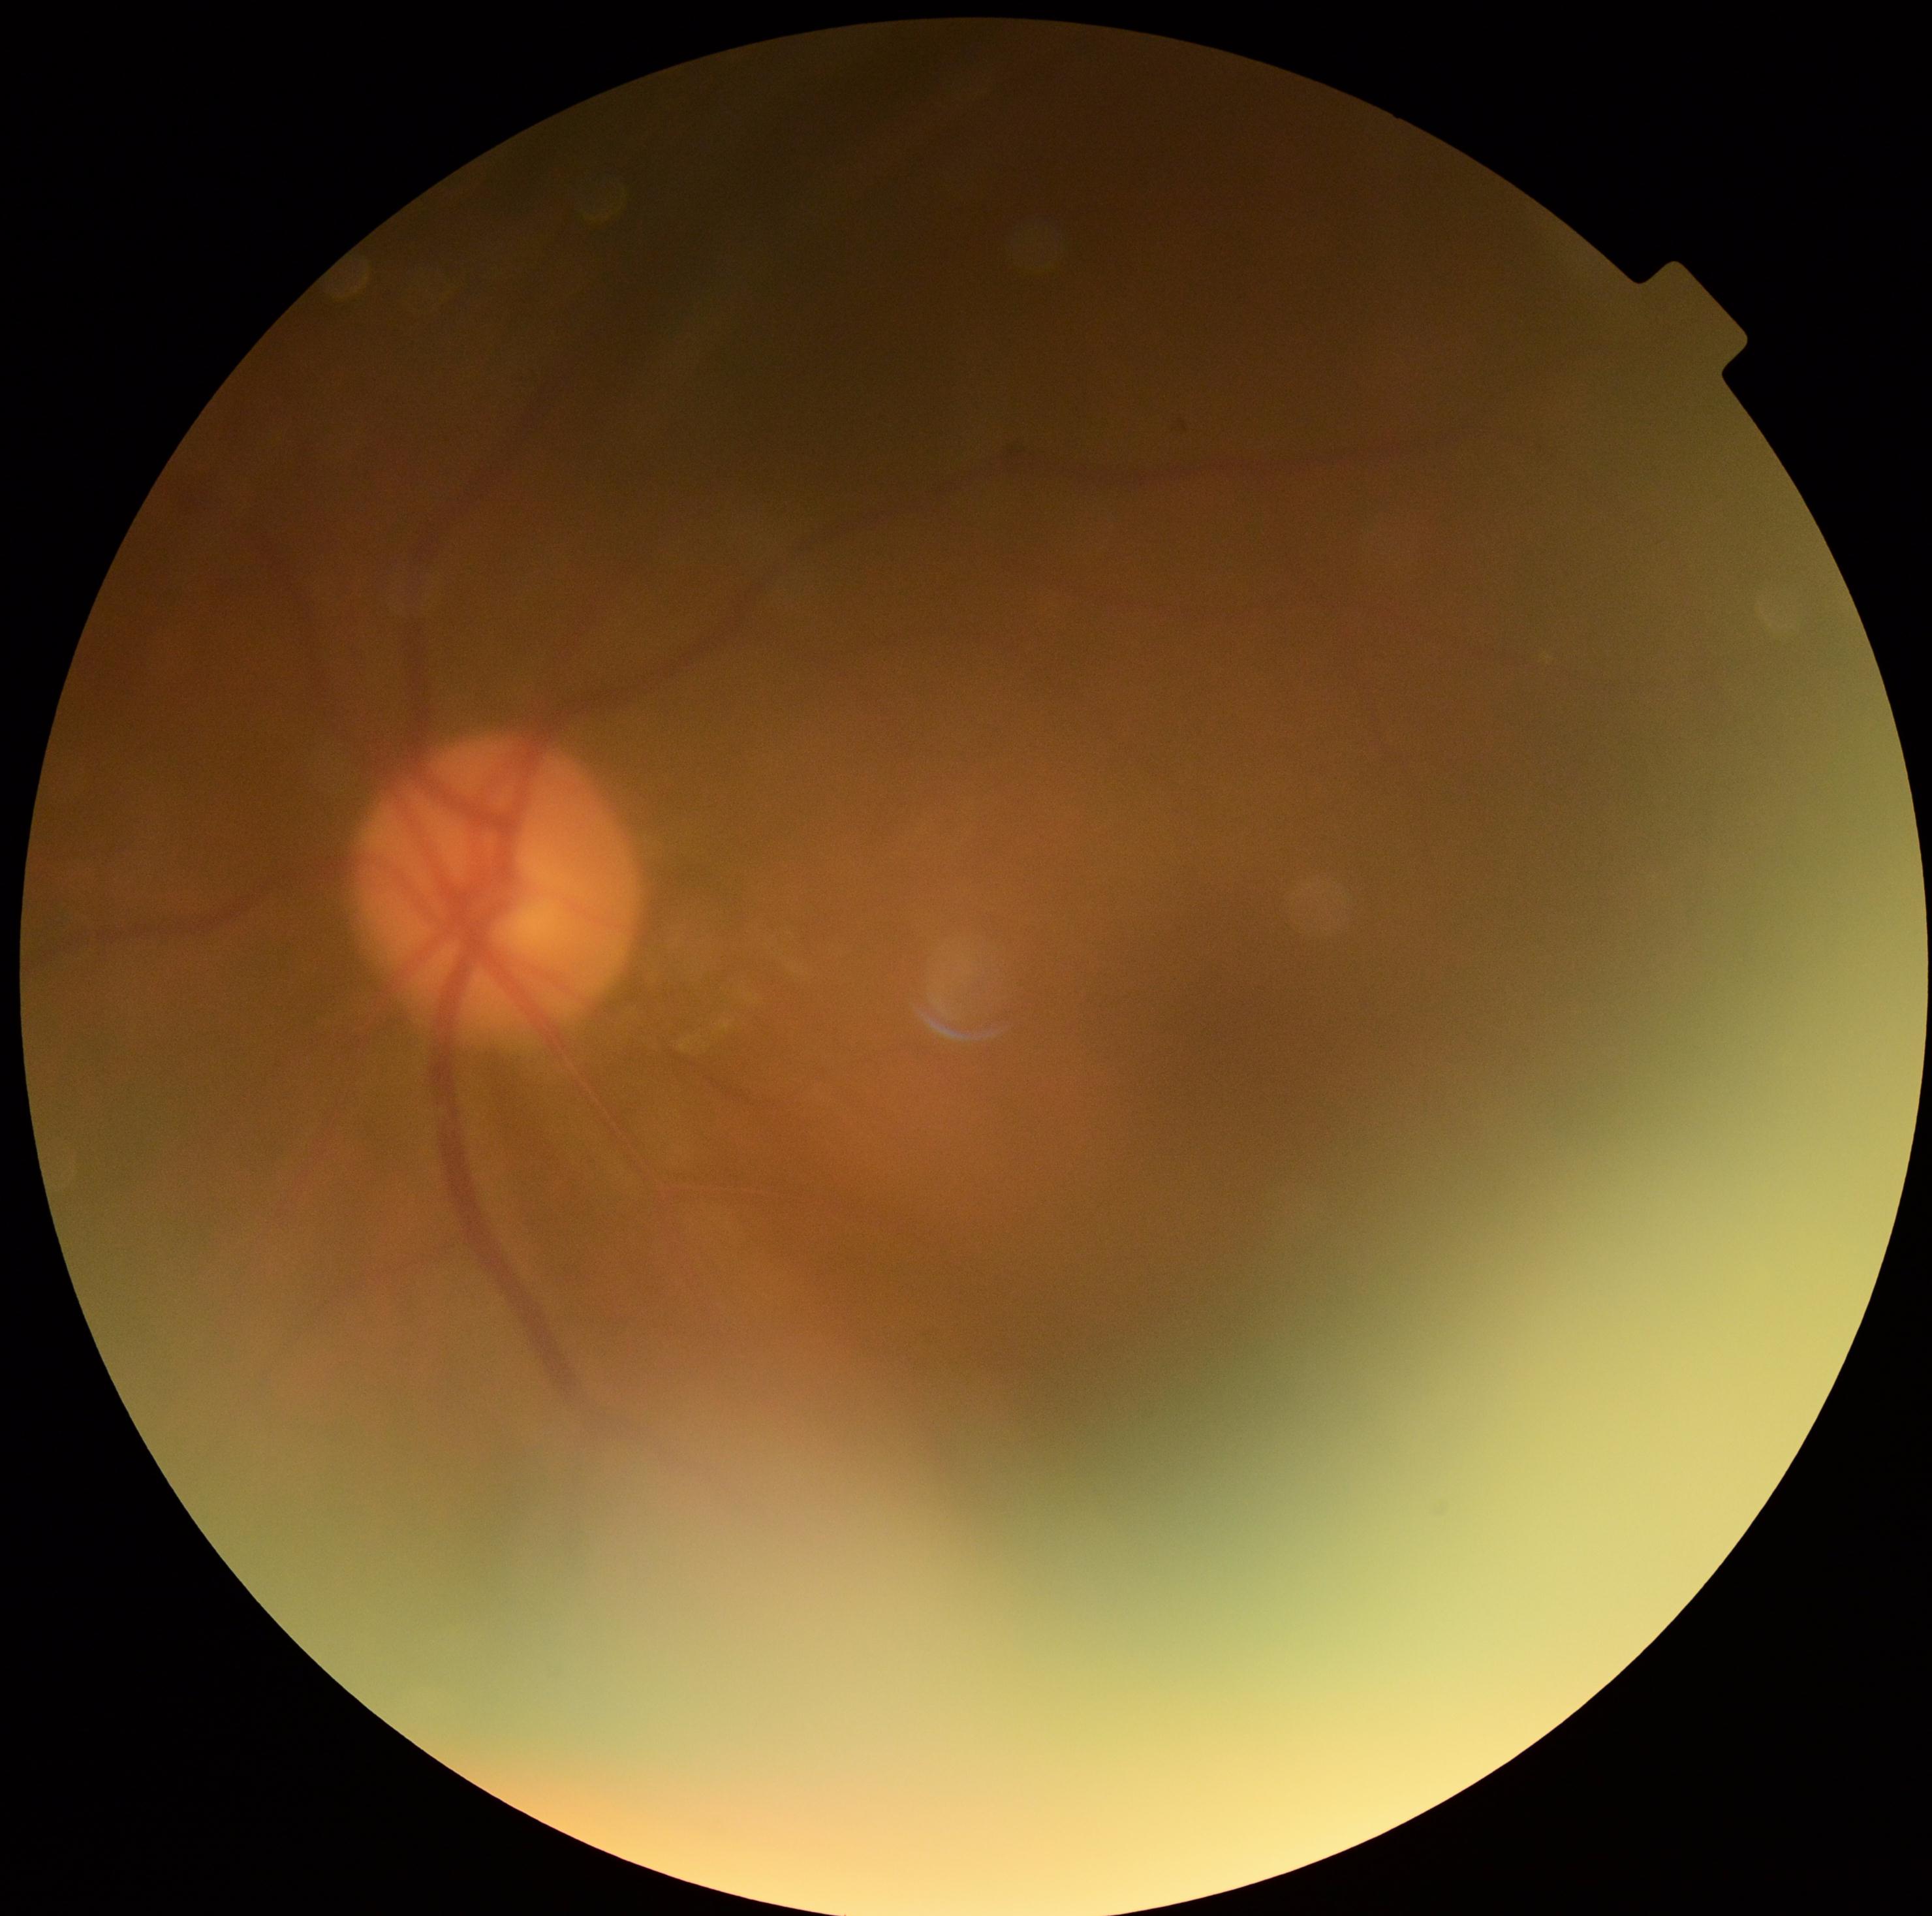

{
  "dr_grade": "0/4"
}